100° field of view (Phoenix ICON); image size 1240x1240; pediatric retinal photograph (wide-field).
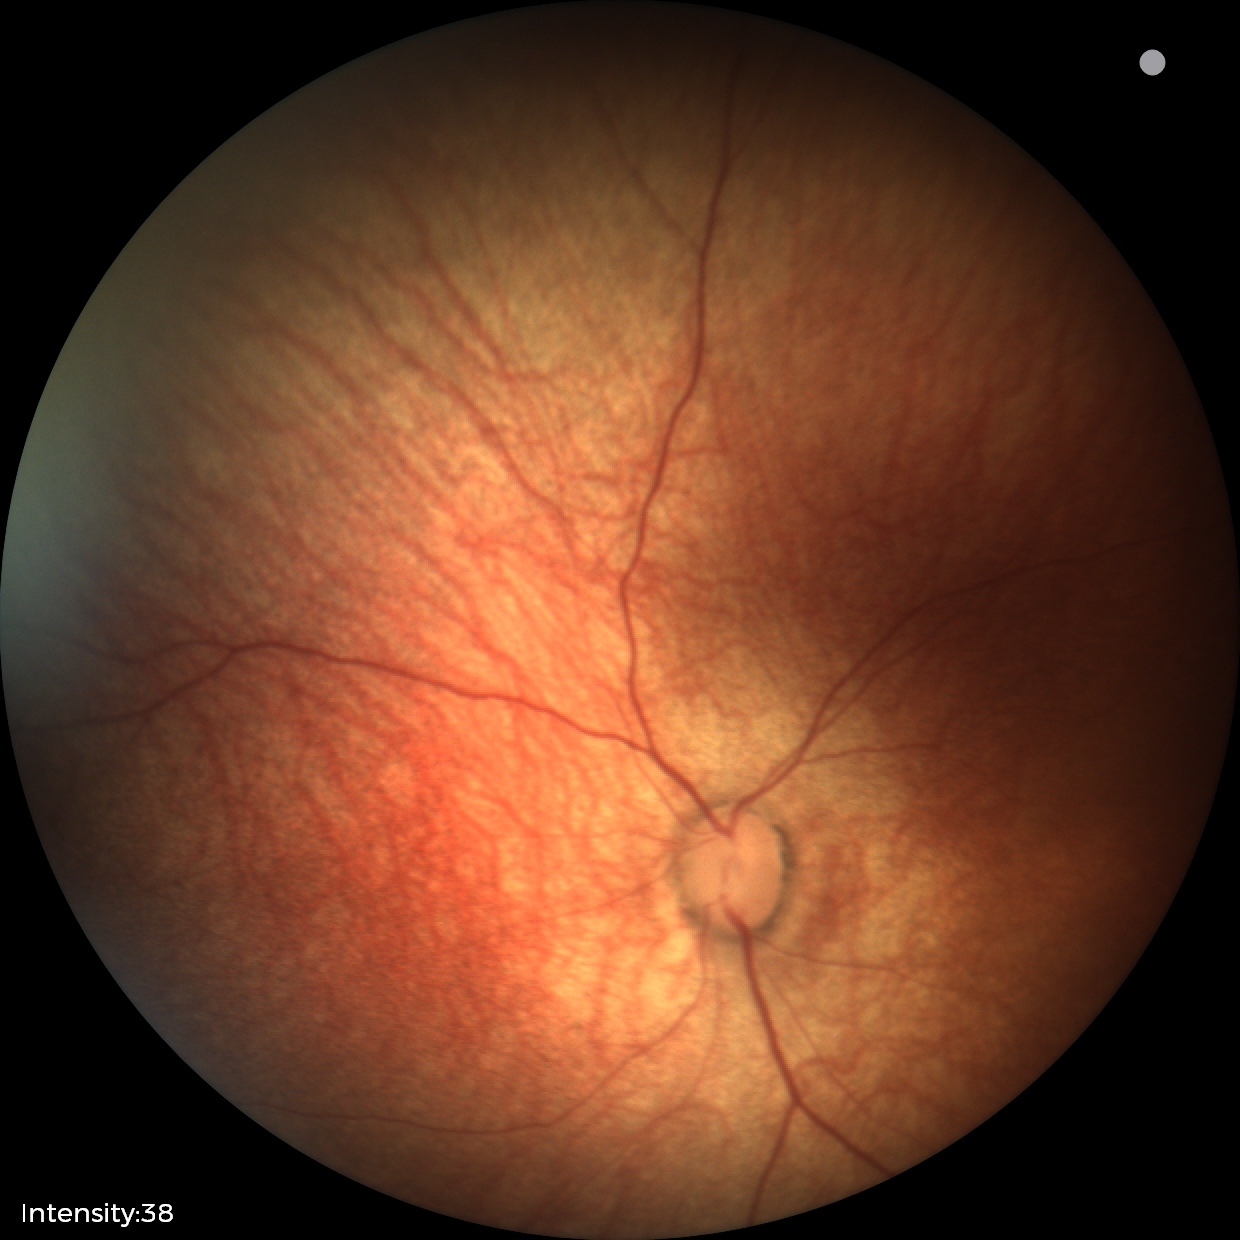

Screening diagnosis: normal retinal appearance.